848 by 848 pixels — 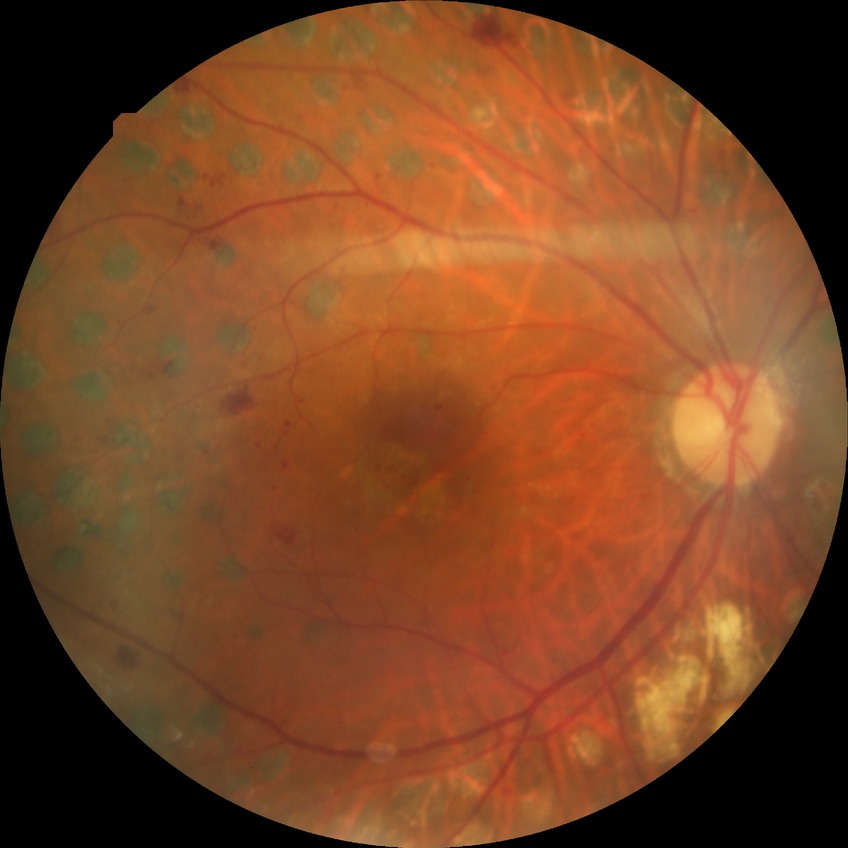 diabetic retinopathy (DR) = PDR (proliferative diabetic retinopathy).